Color fundus photograph: 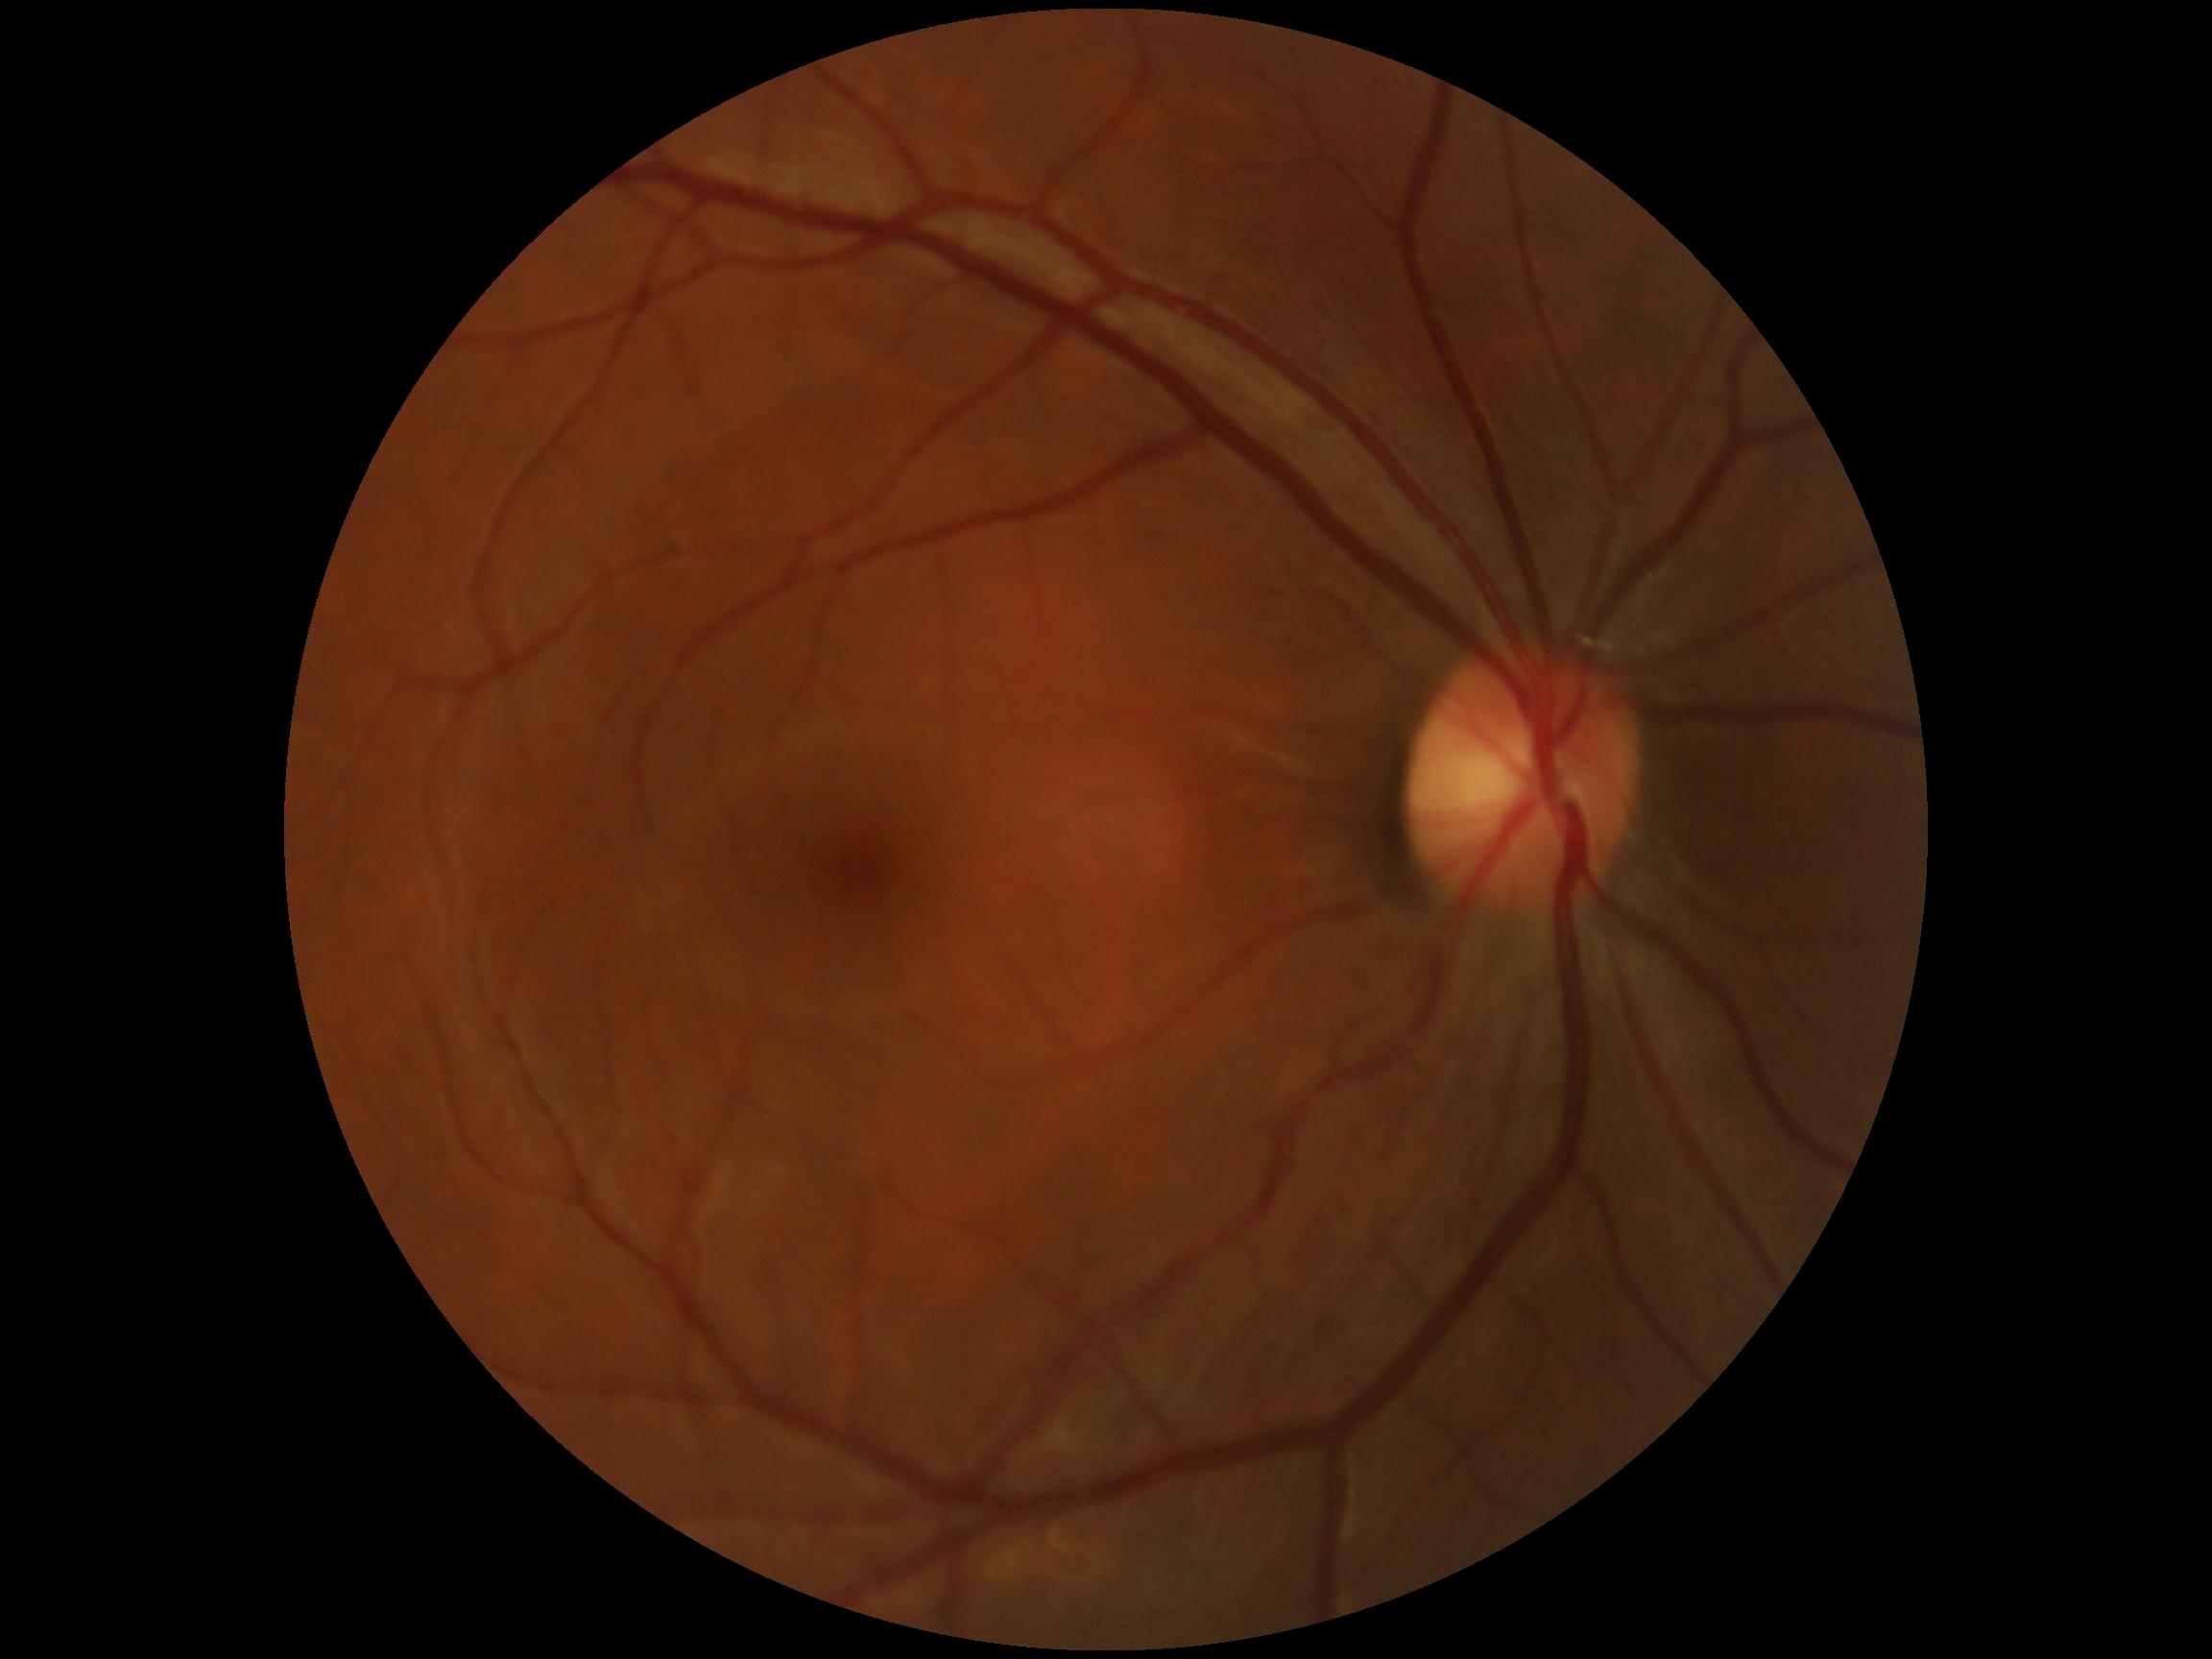
DR: 0.
No diabetic retinal disease findings.